Wide-field fundus image from infant ROP screening:
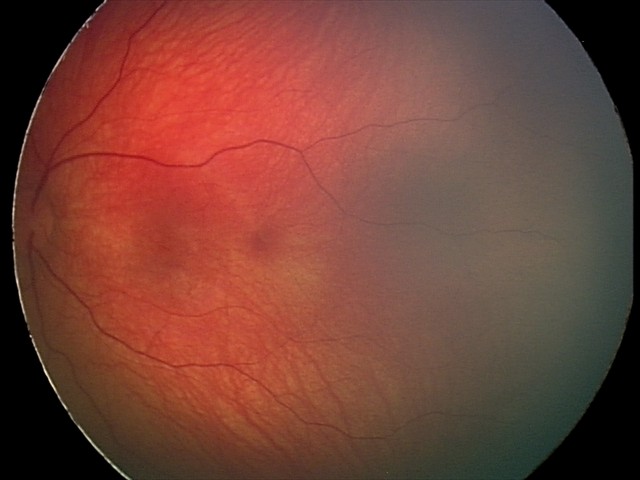 Screening examination consistent with retinal hemorrhages.